45° field of view, NIDEK AFC-230 fundus camera: 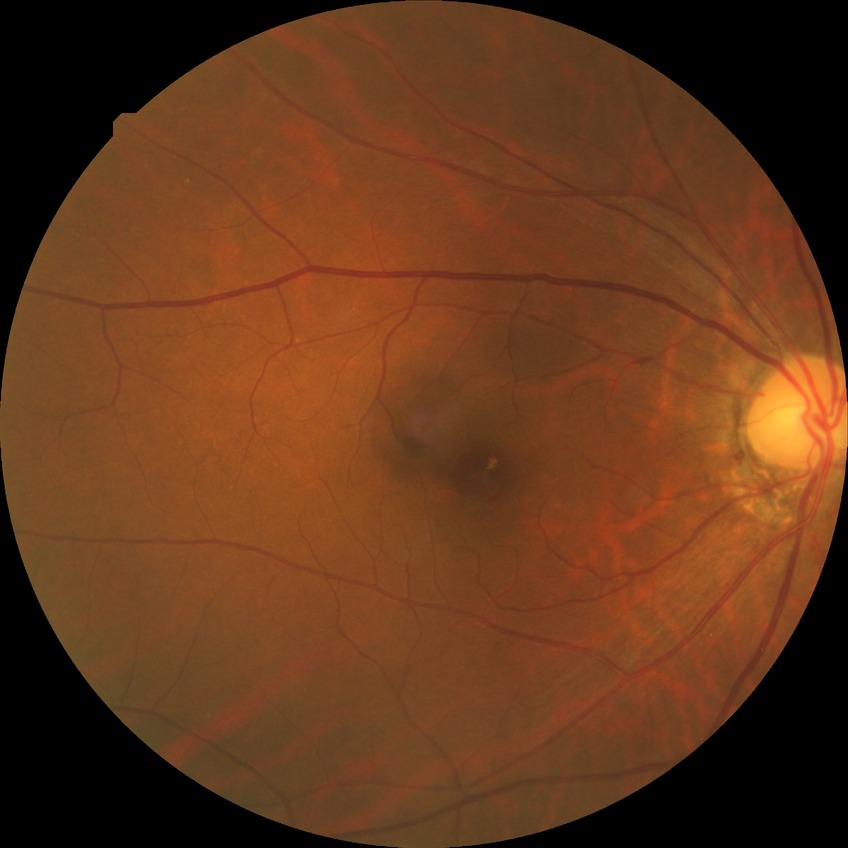 Annotations:
• DR impression: no DR findings
• DR stage: NDR